Without pupil dilation. Modified Davis grading. Posterior pole photograph: 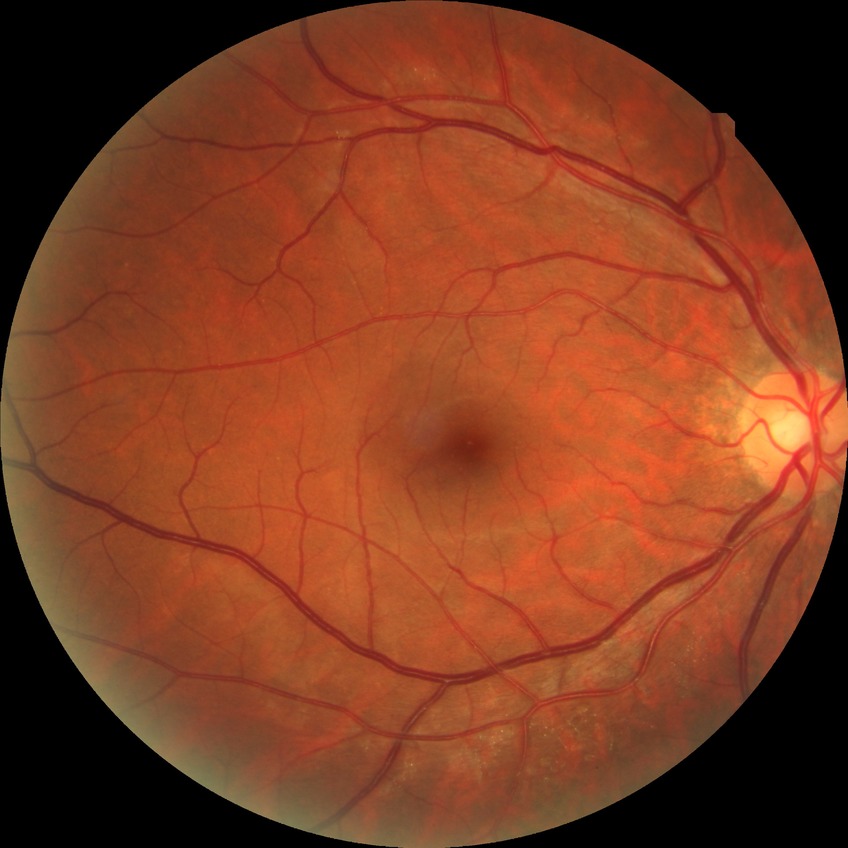
Diabetic retinopathy (DR) is simple diabetic retinopathy (SDR).